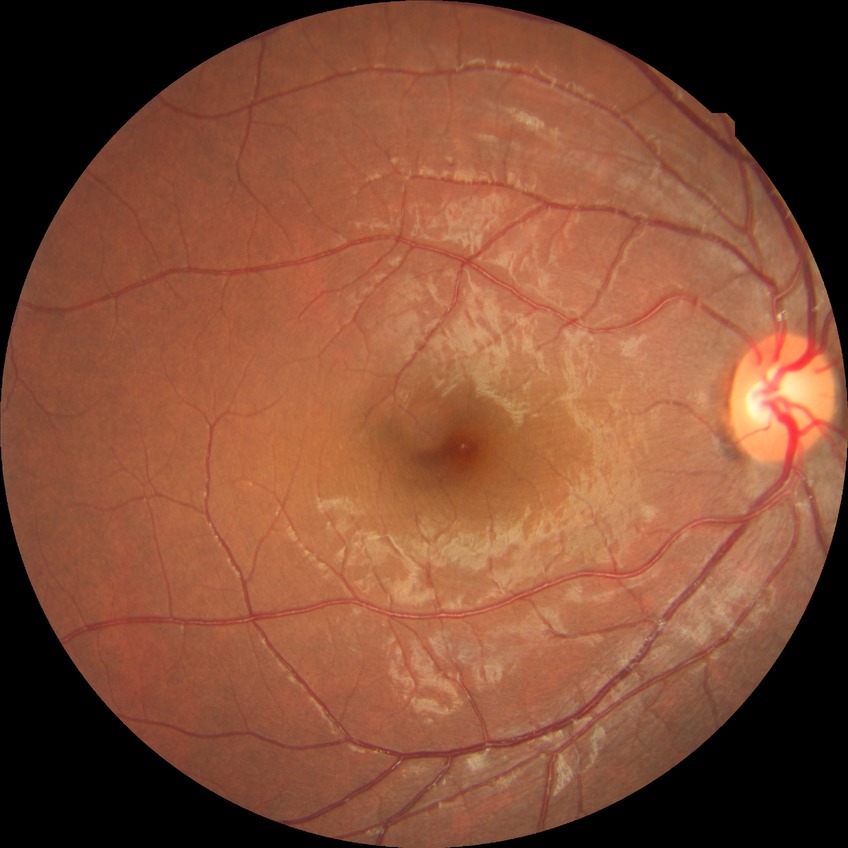

Retinopathy grade is no diabetic retinopathy.